2352 x 1568 pixels — 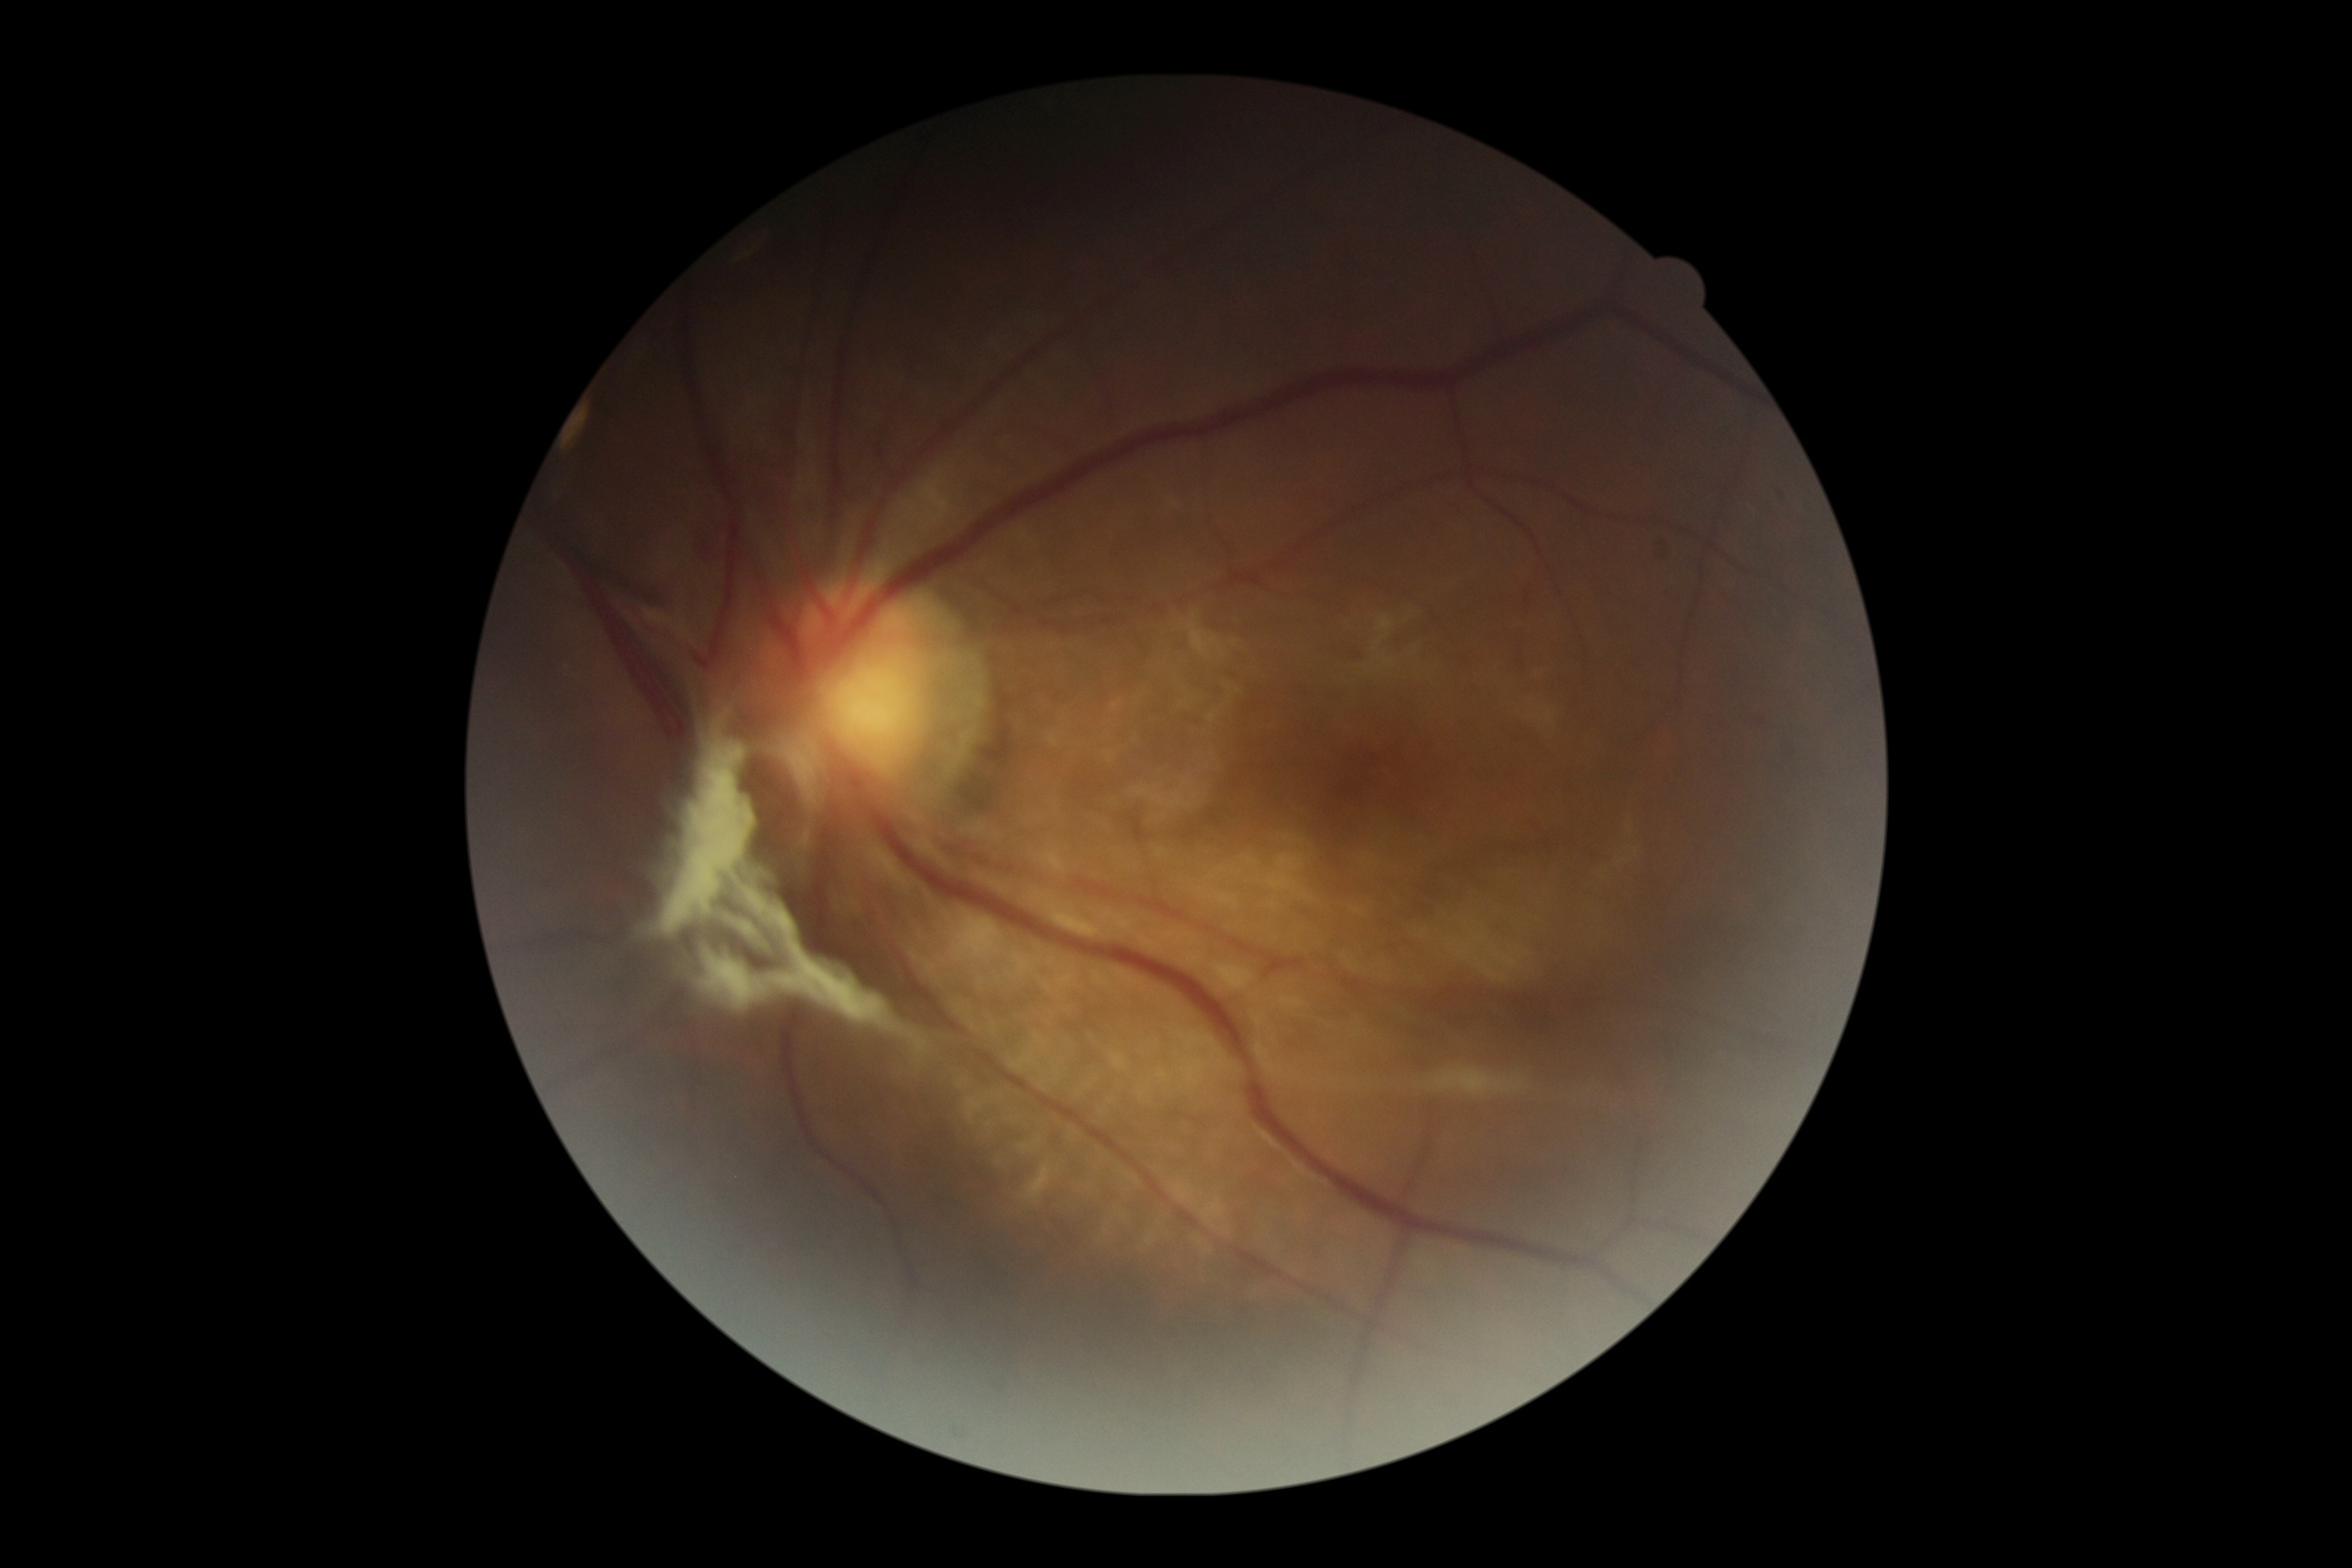 diabetic retinopathy=grade 4 (PDR).